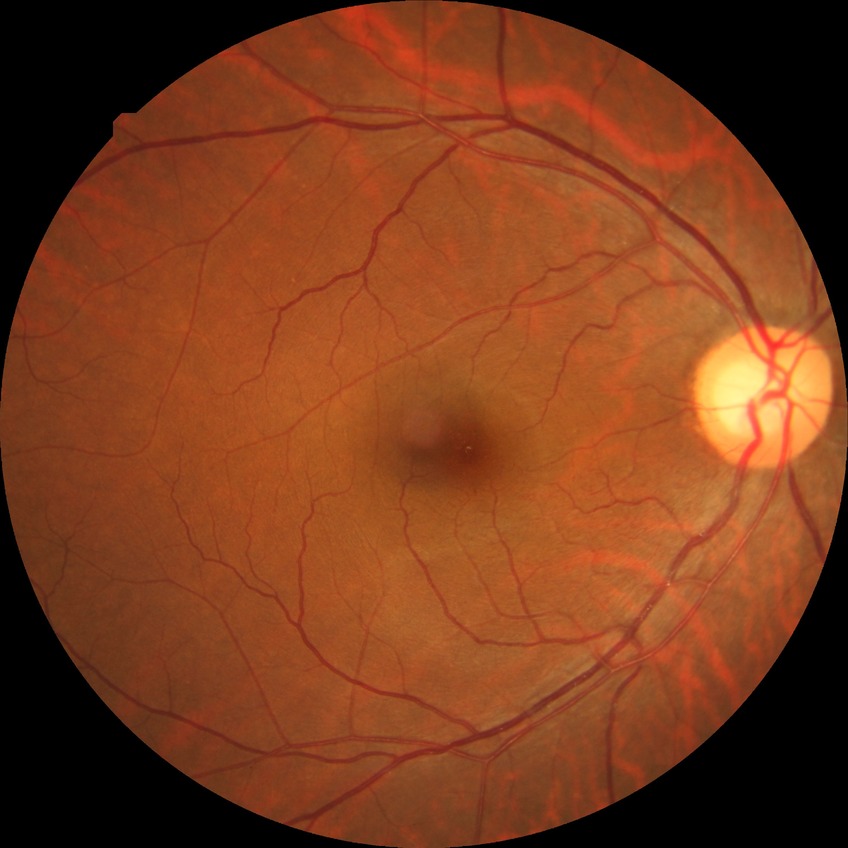 Diabetic retinopathy (DR) is no diabetic retinopathy (NDR).